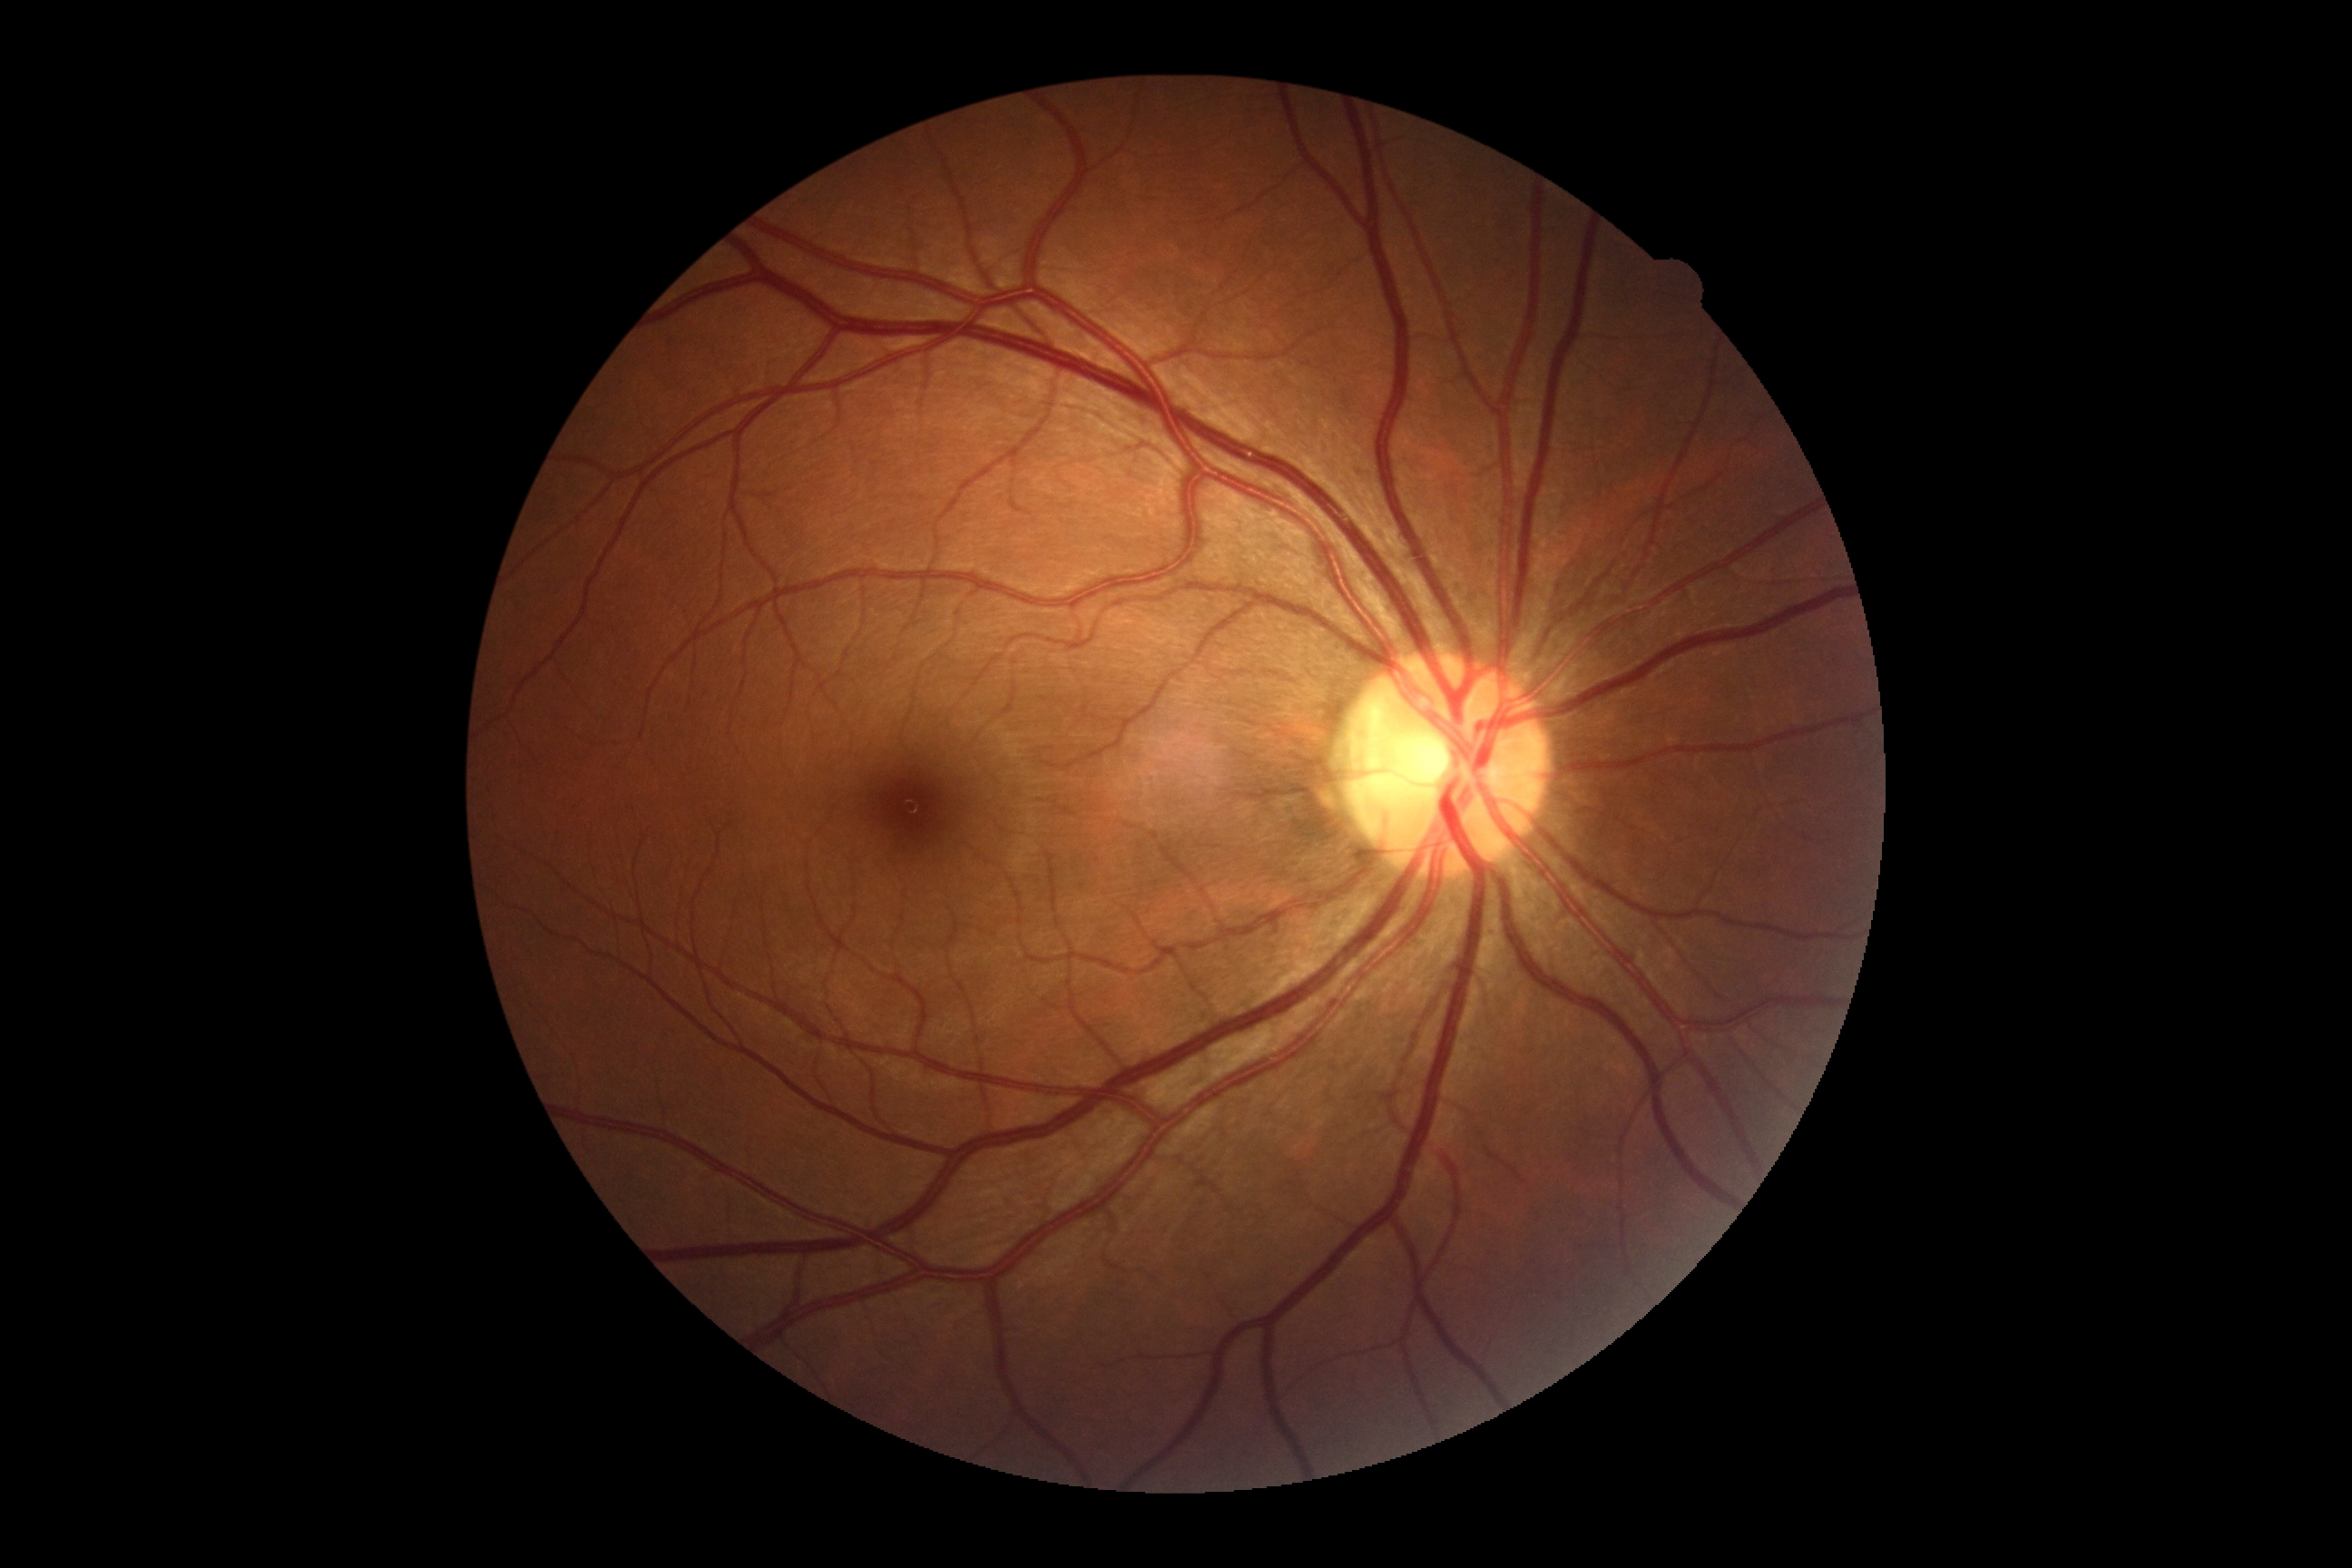 Findings:
– DR severity — no apparent retinopathy (grade 0)